2228 by 1652 pixels. Retinal fundus photograph
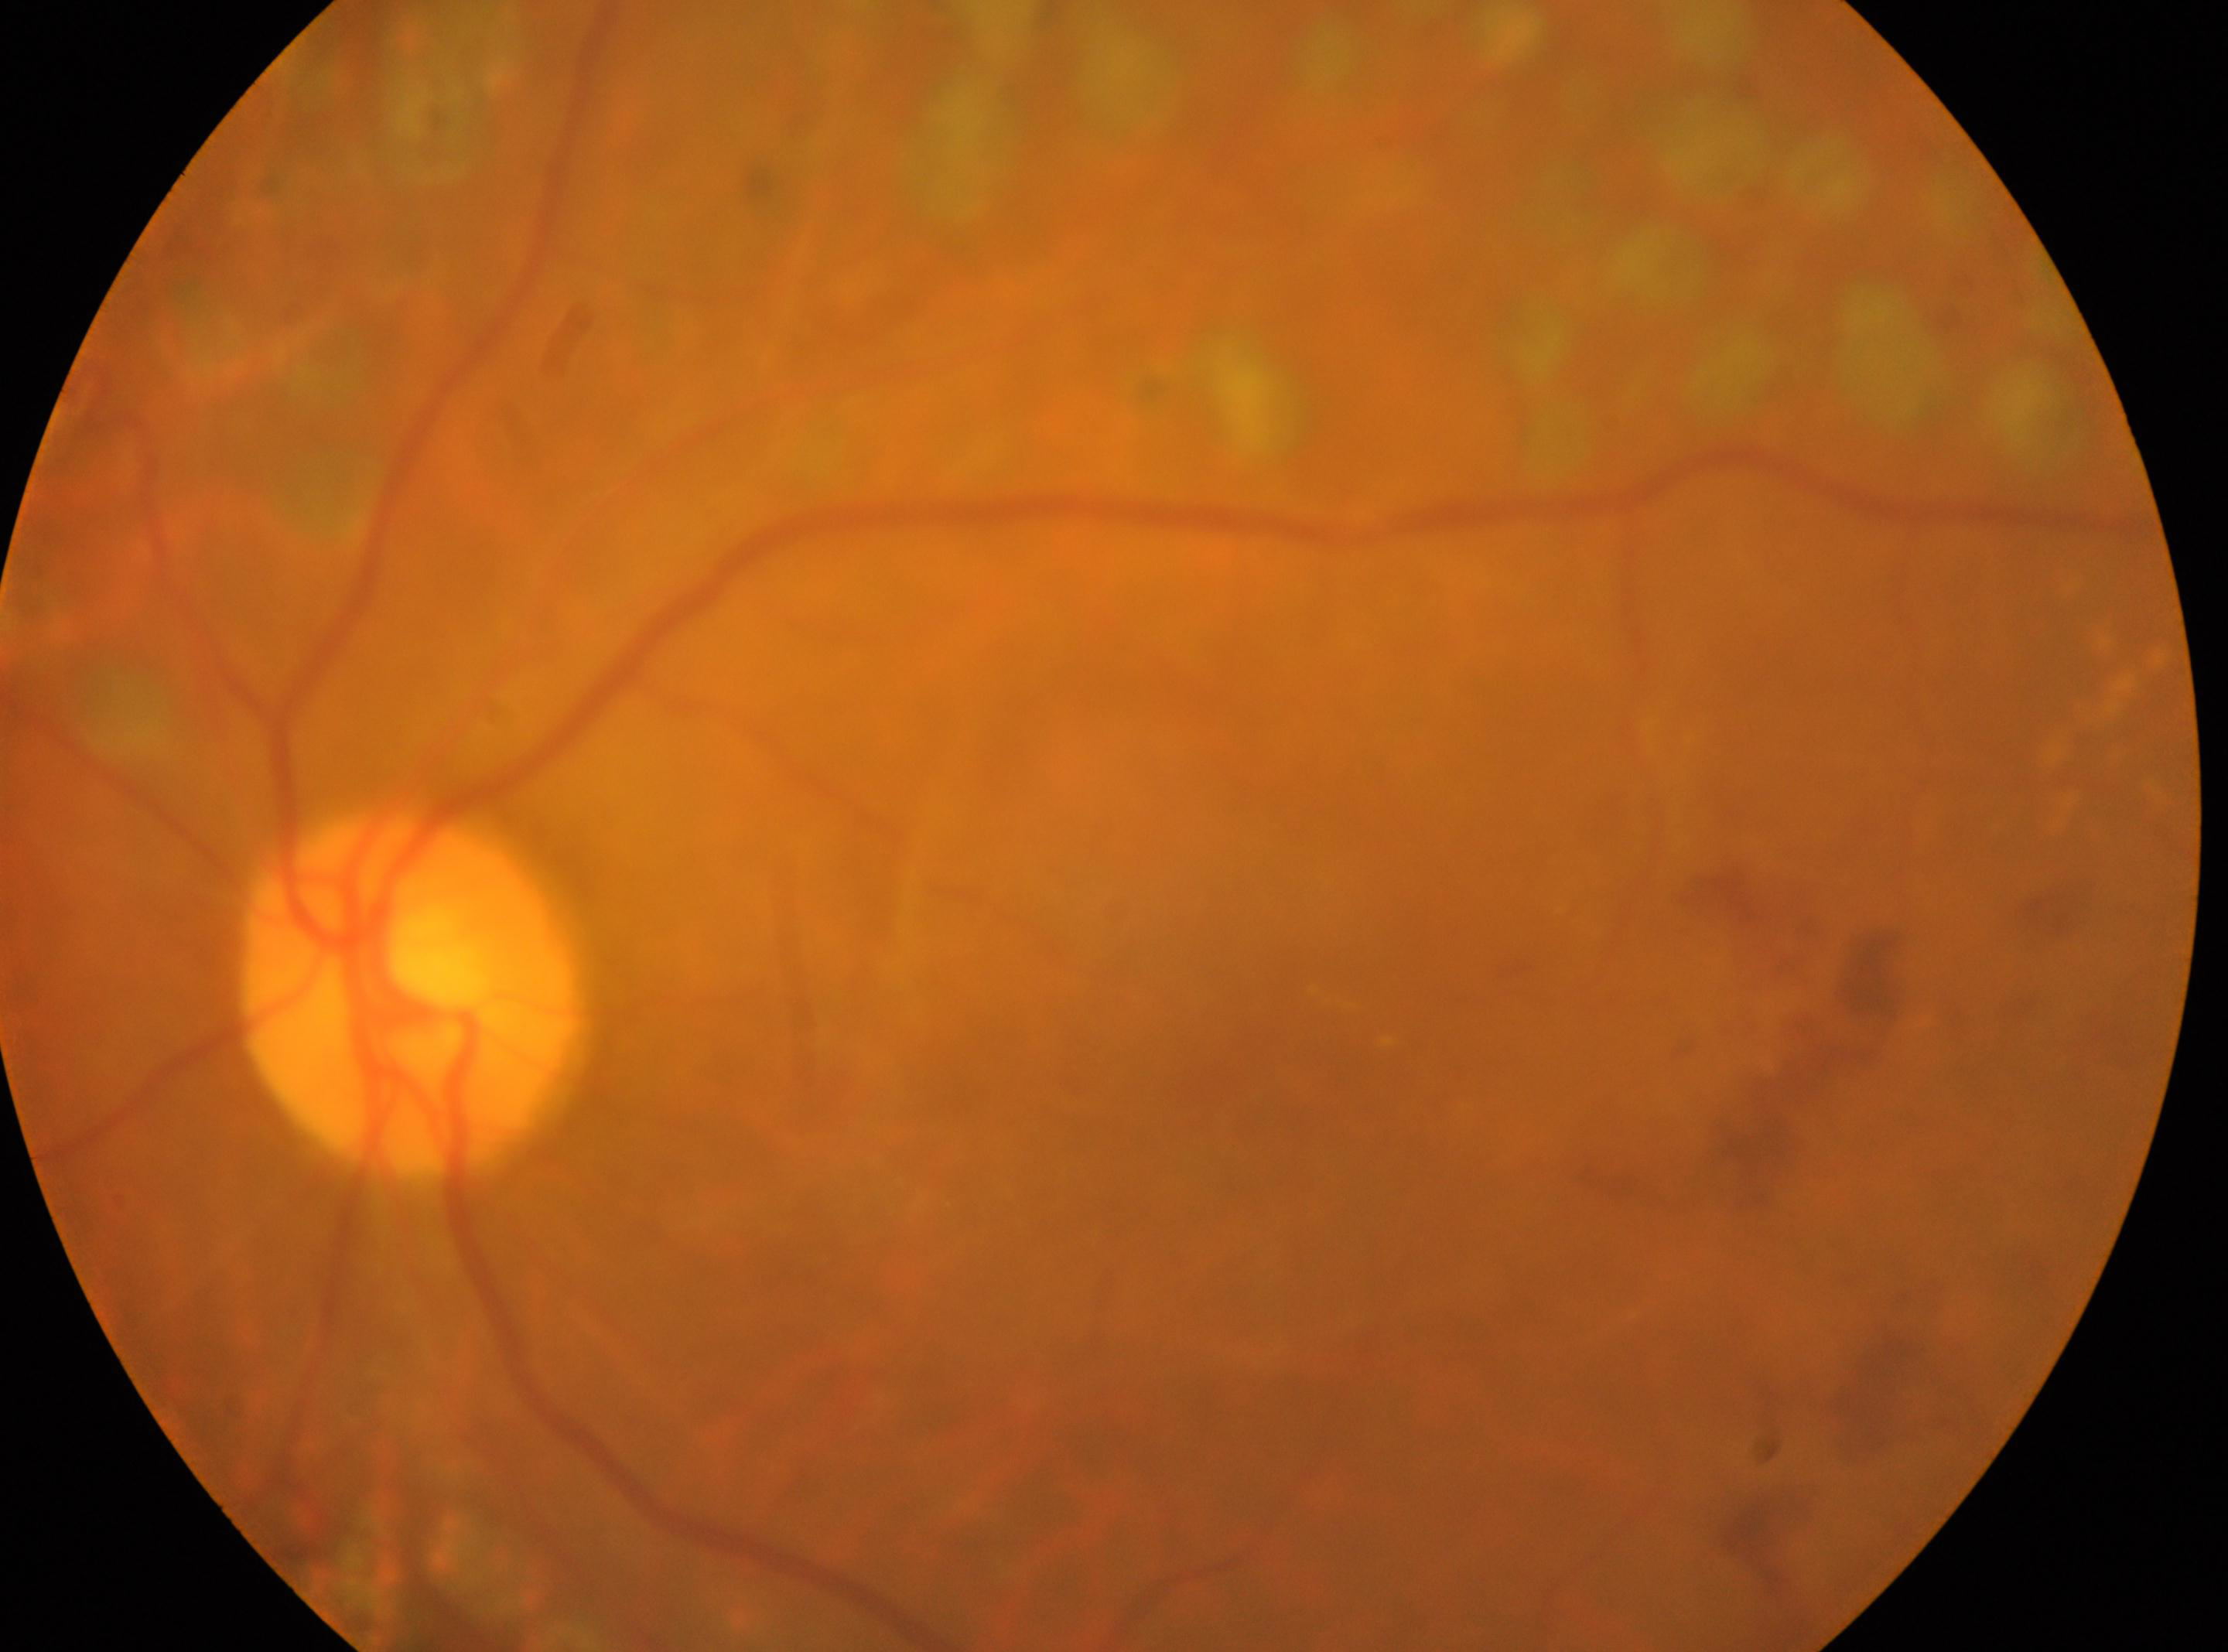

Diabetic retinopathy severity is laser-treated DR. Optic disc: (x=410, y=992). Imaged eye: oculus sinister. Fovea centralis located at (x=1266, y=1080).